1932x1910.
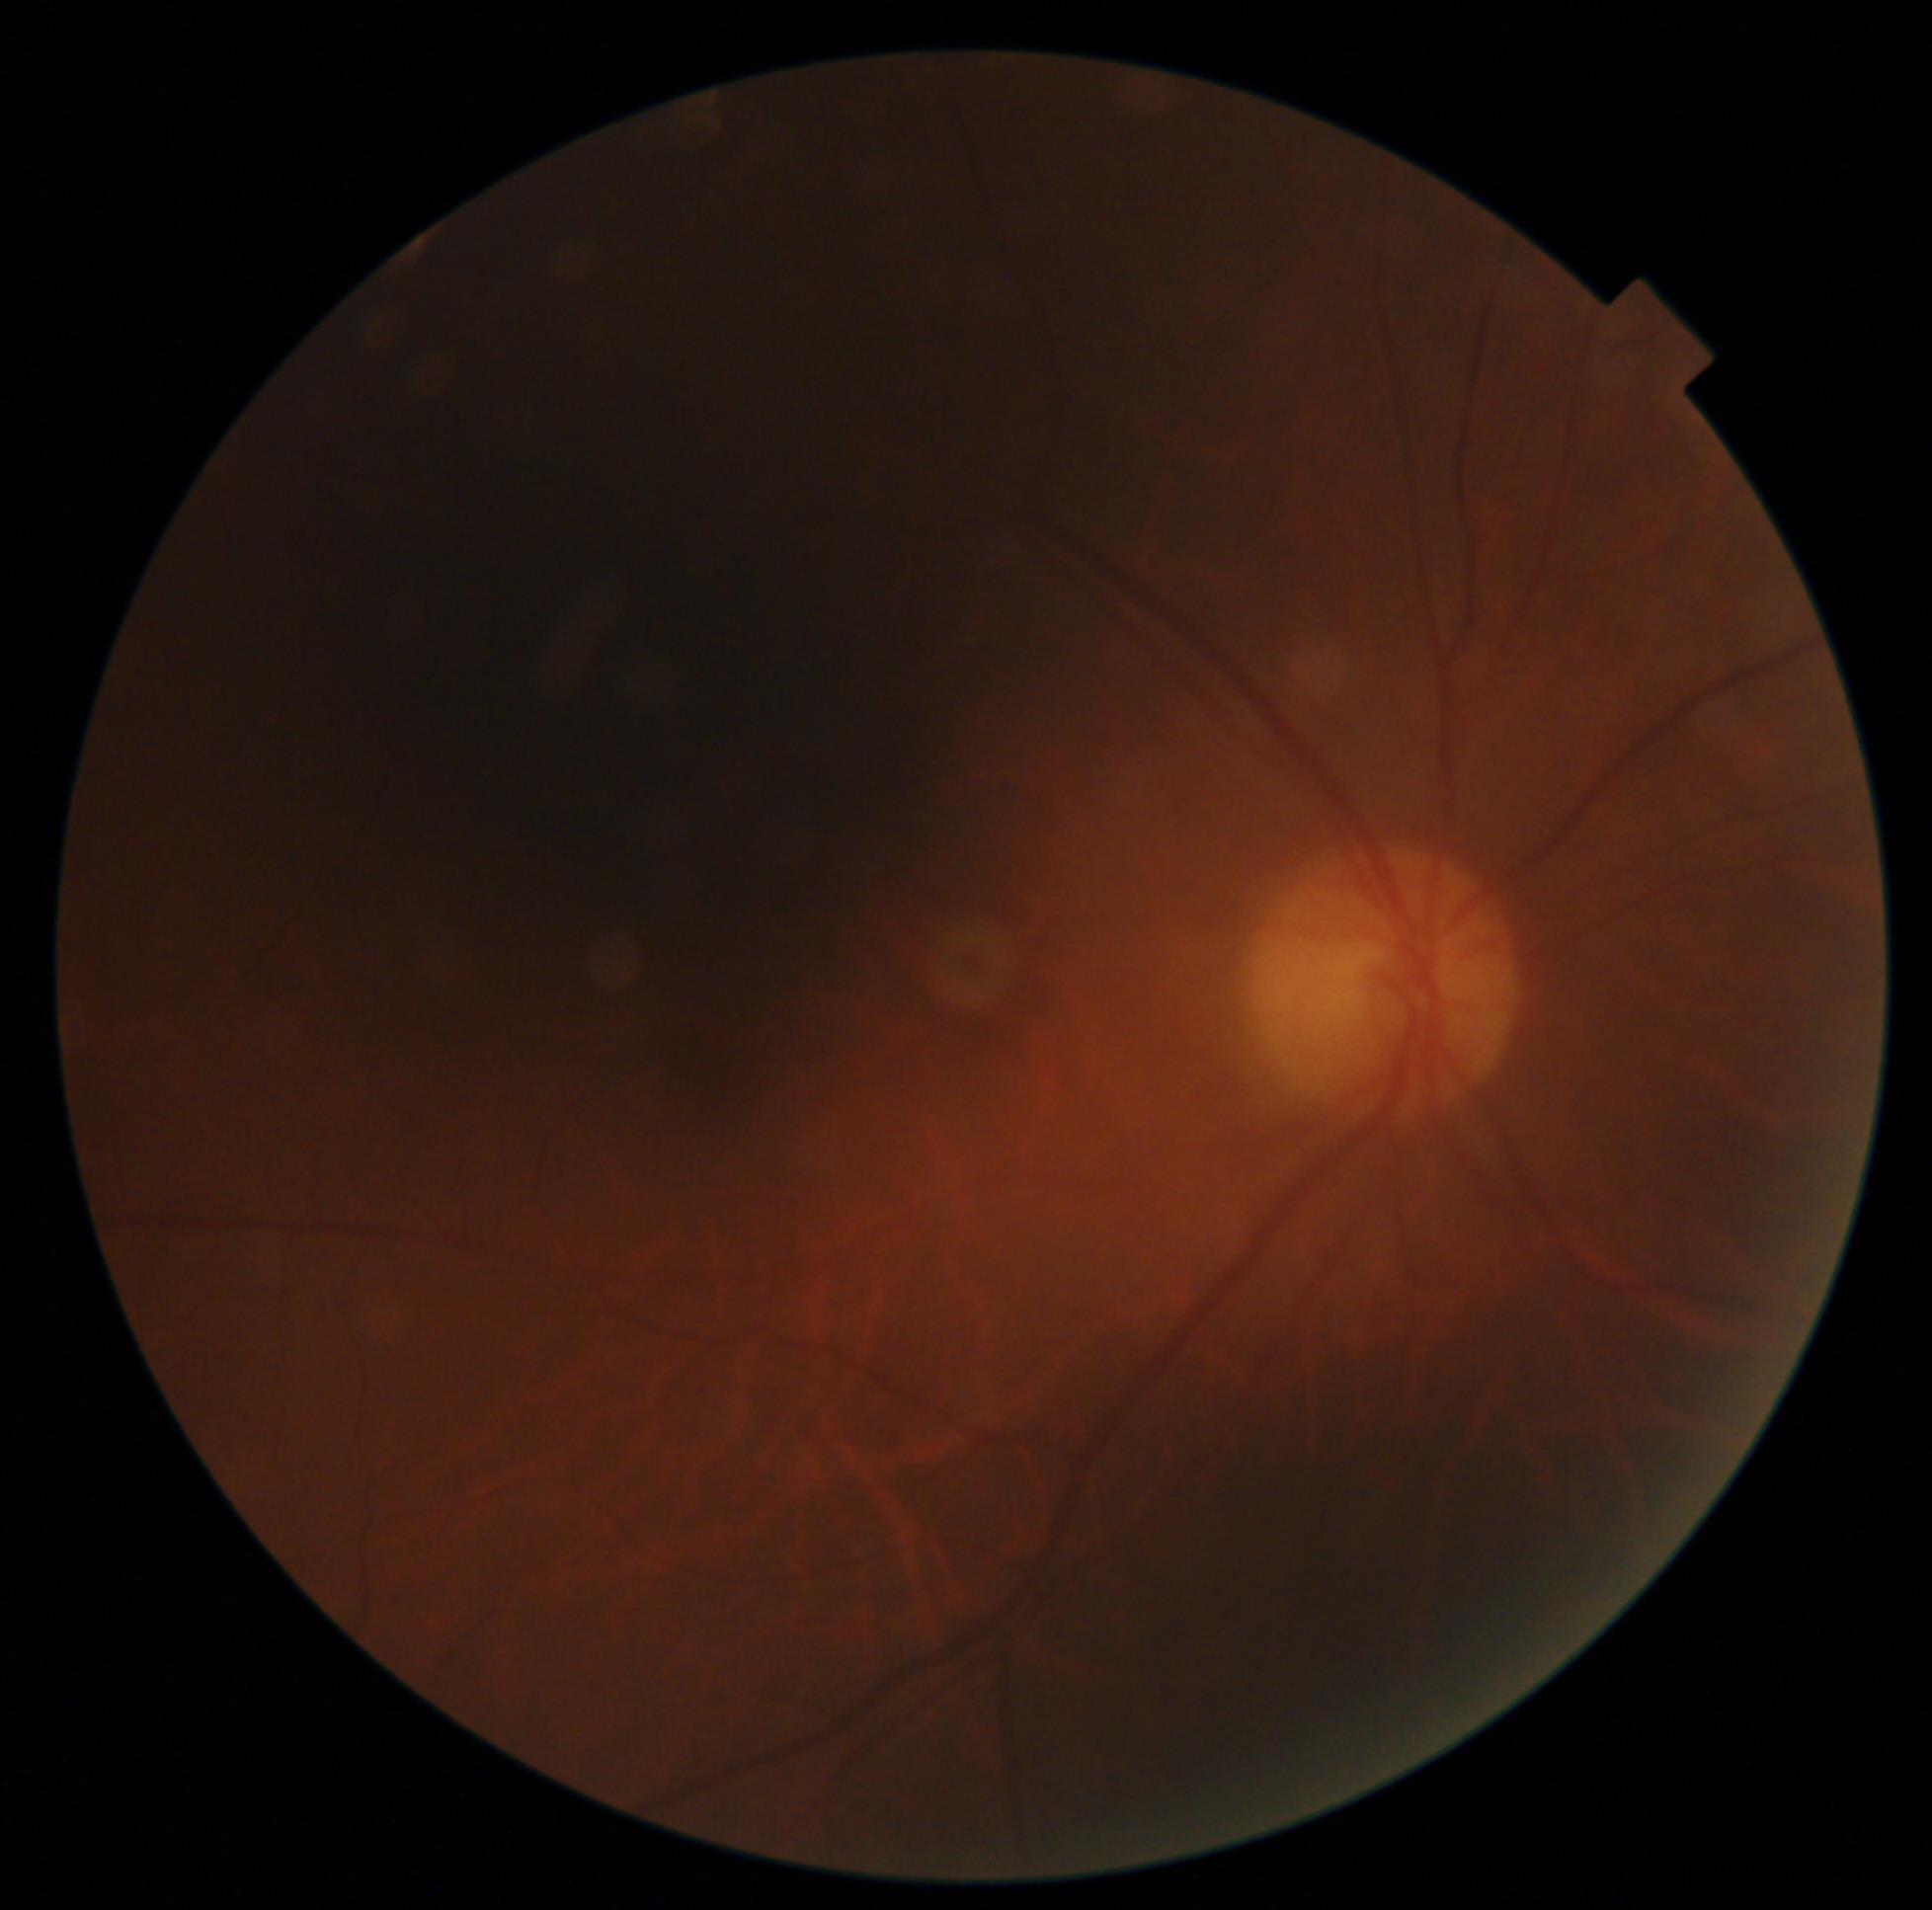 retinopathy@ungradable due to poor image quality; image quality@insufficient for DR assessment.